45-degree field of view: 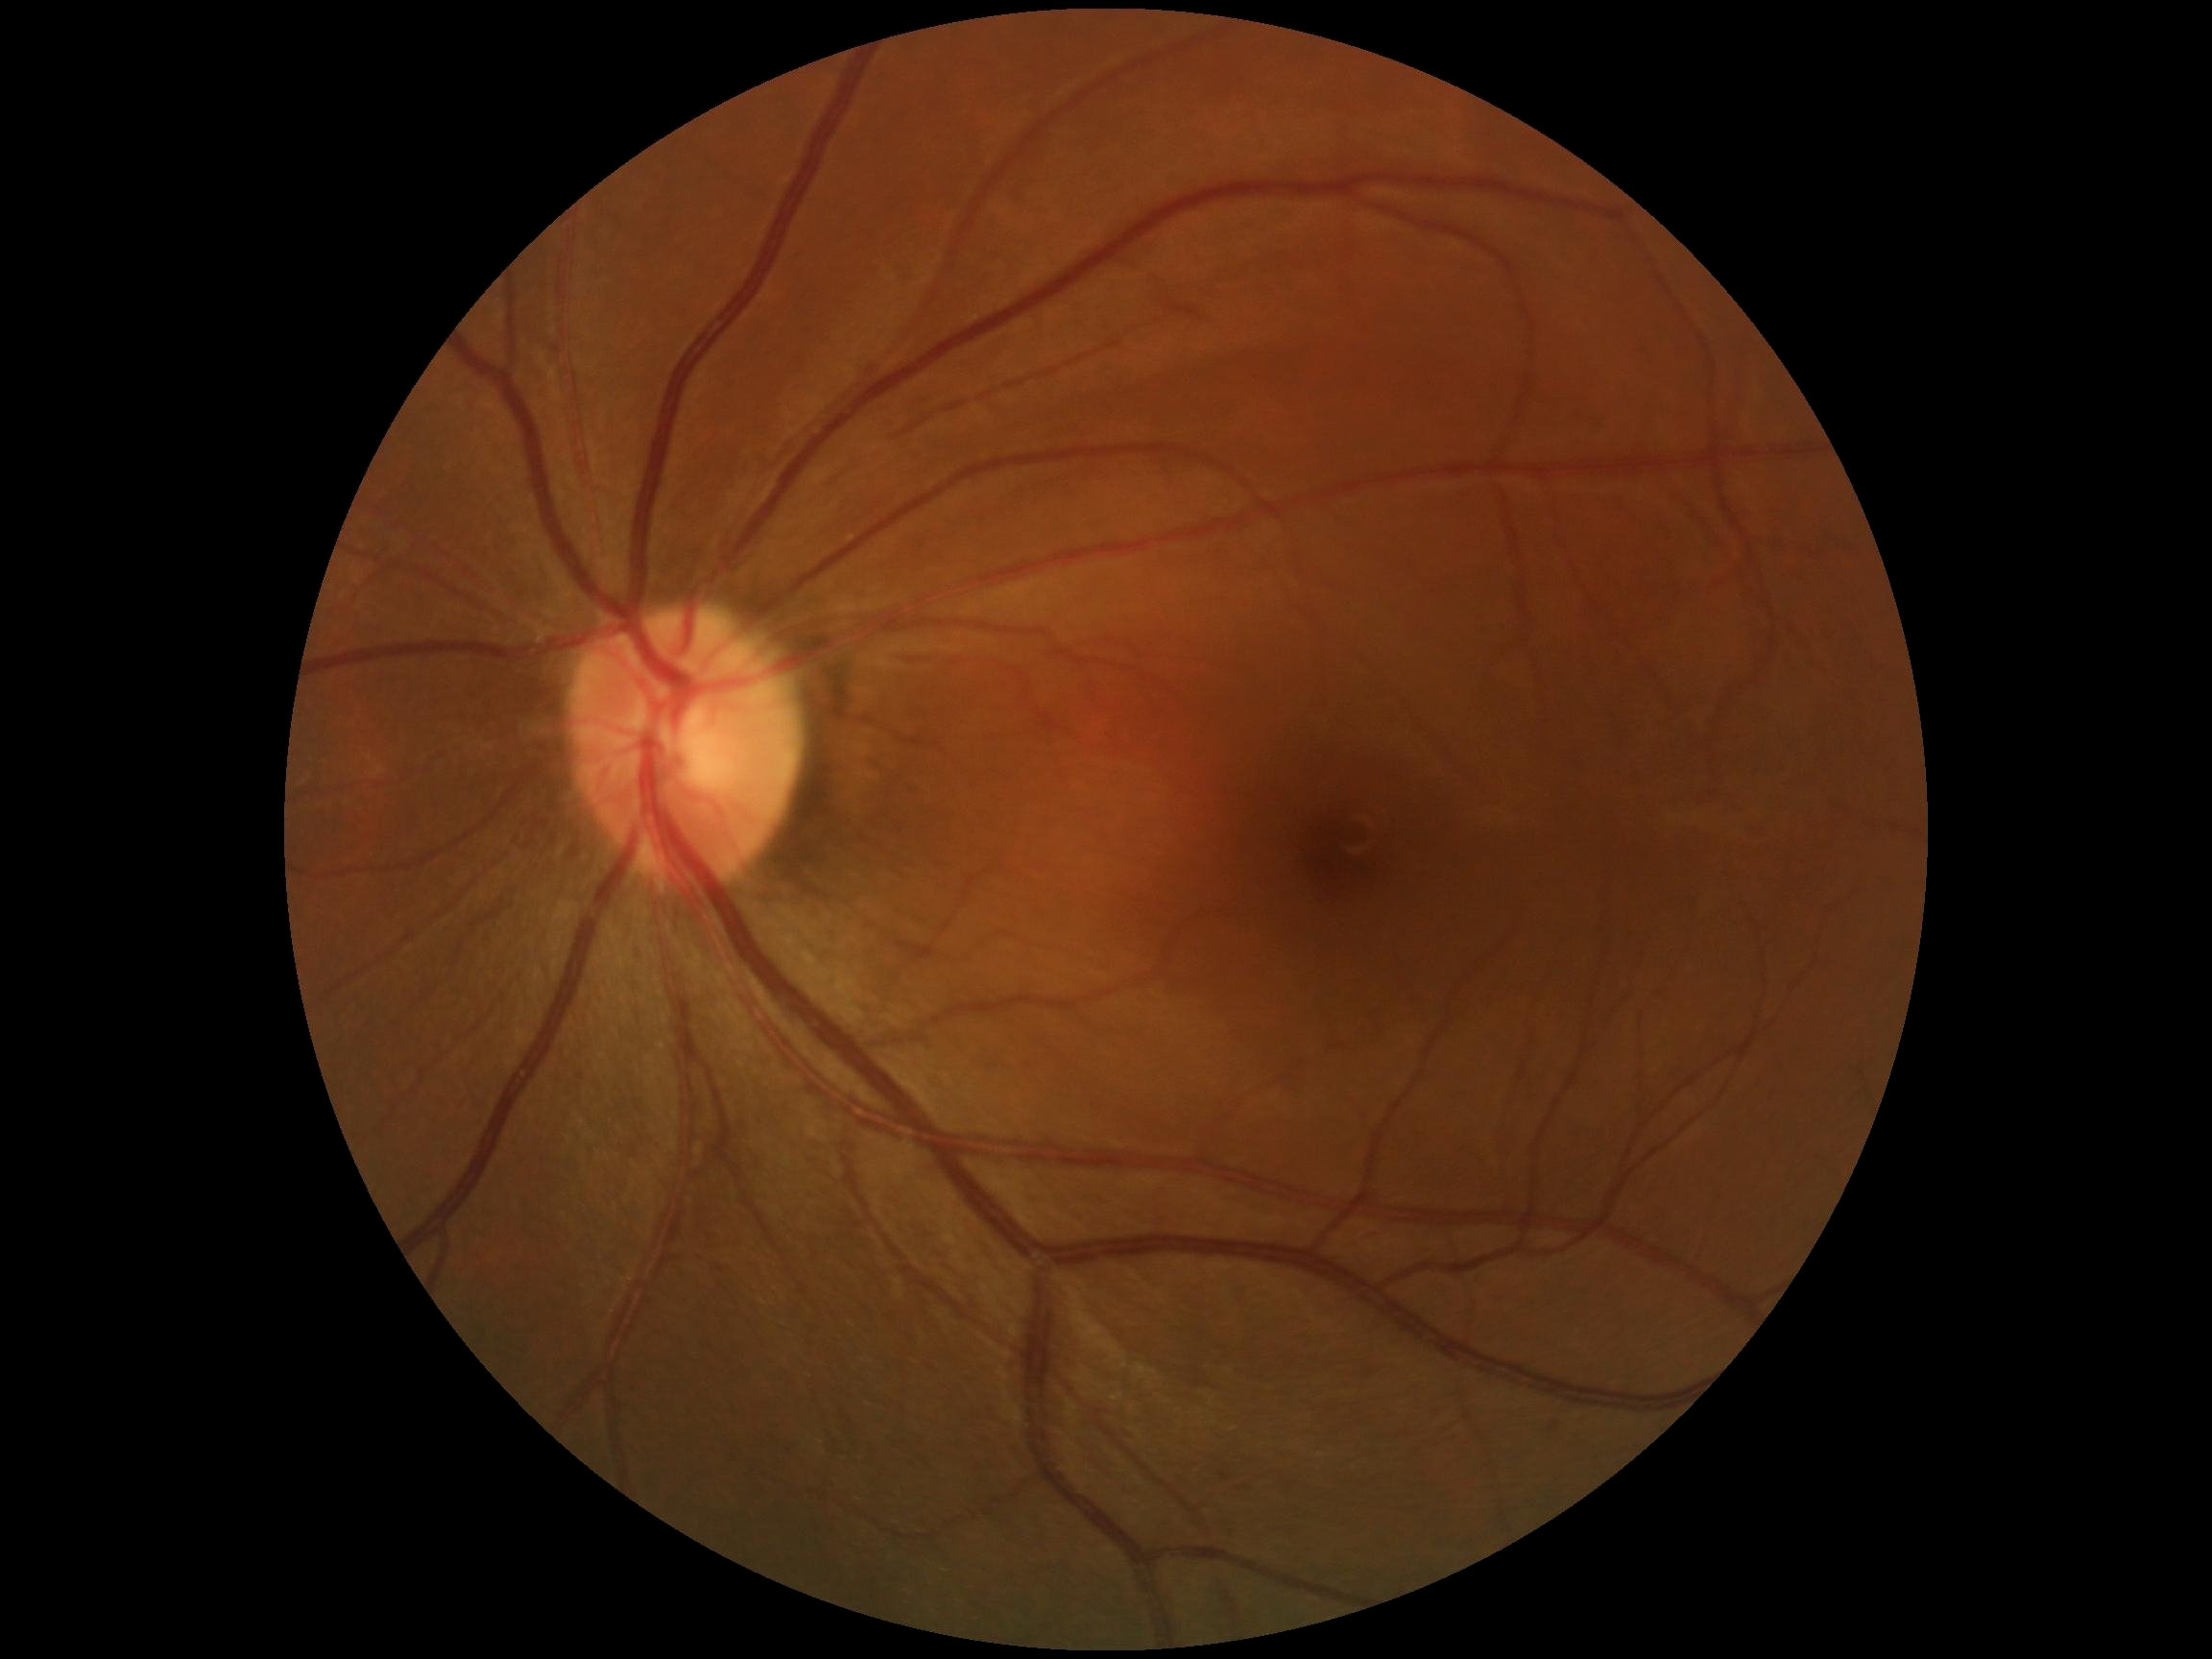 Diabetic retinopathy (DR): grade 0.